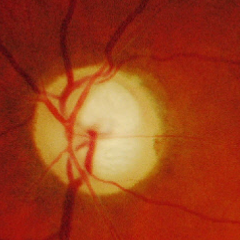 This fundus photograph shows severe glaucomatous damage.